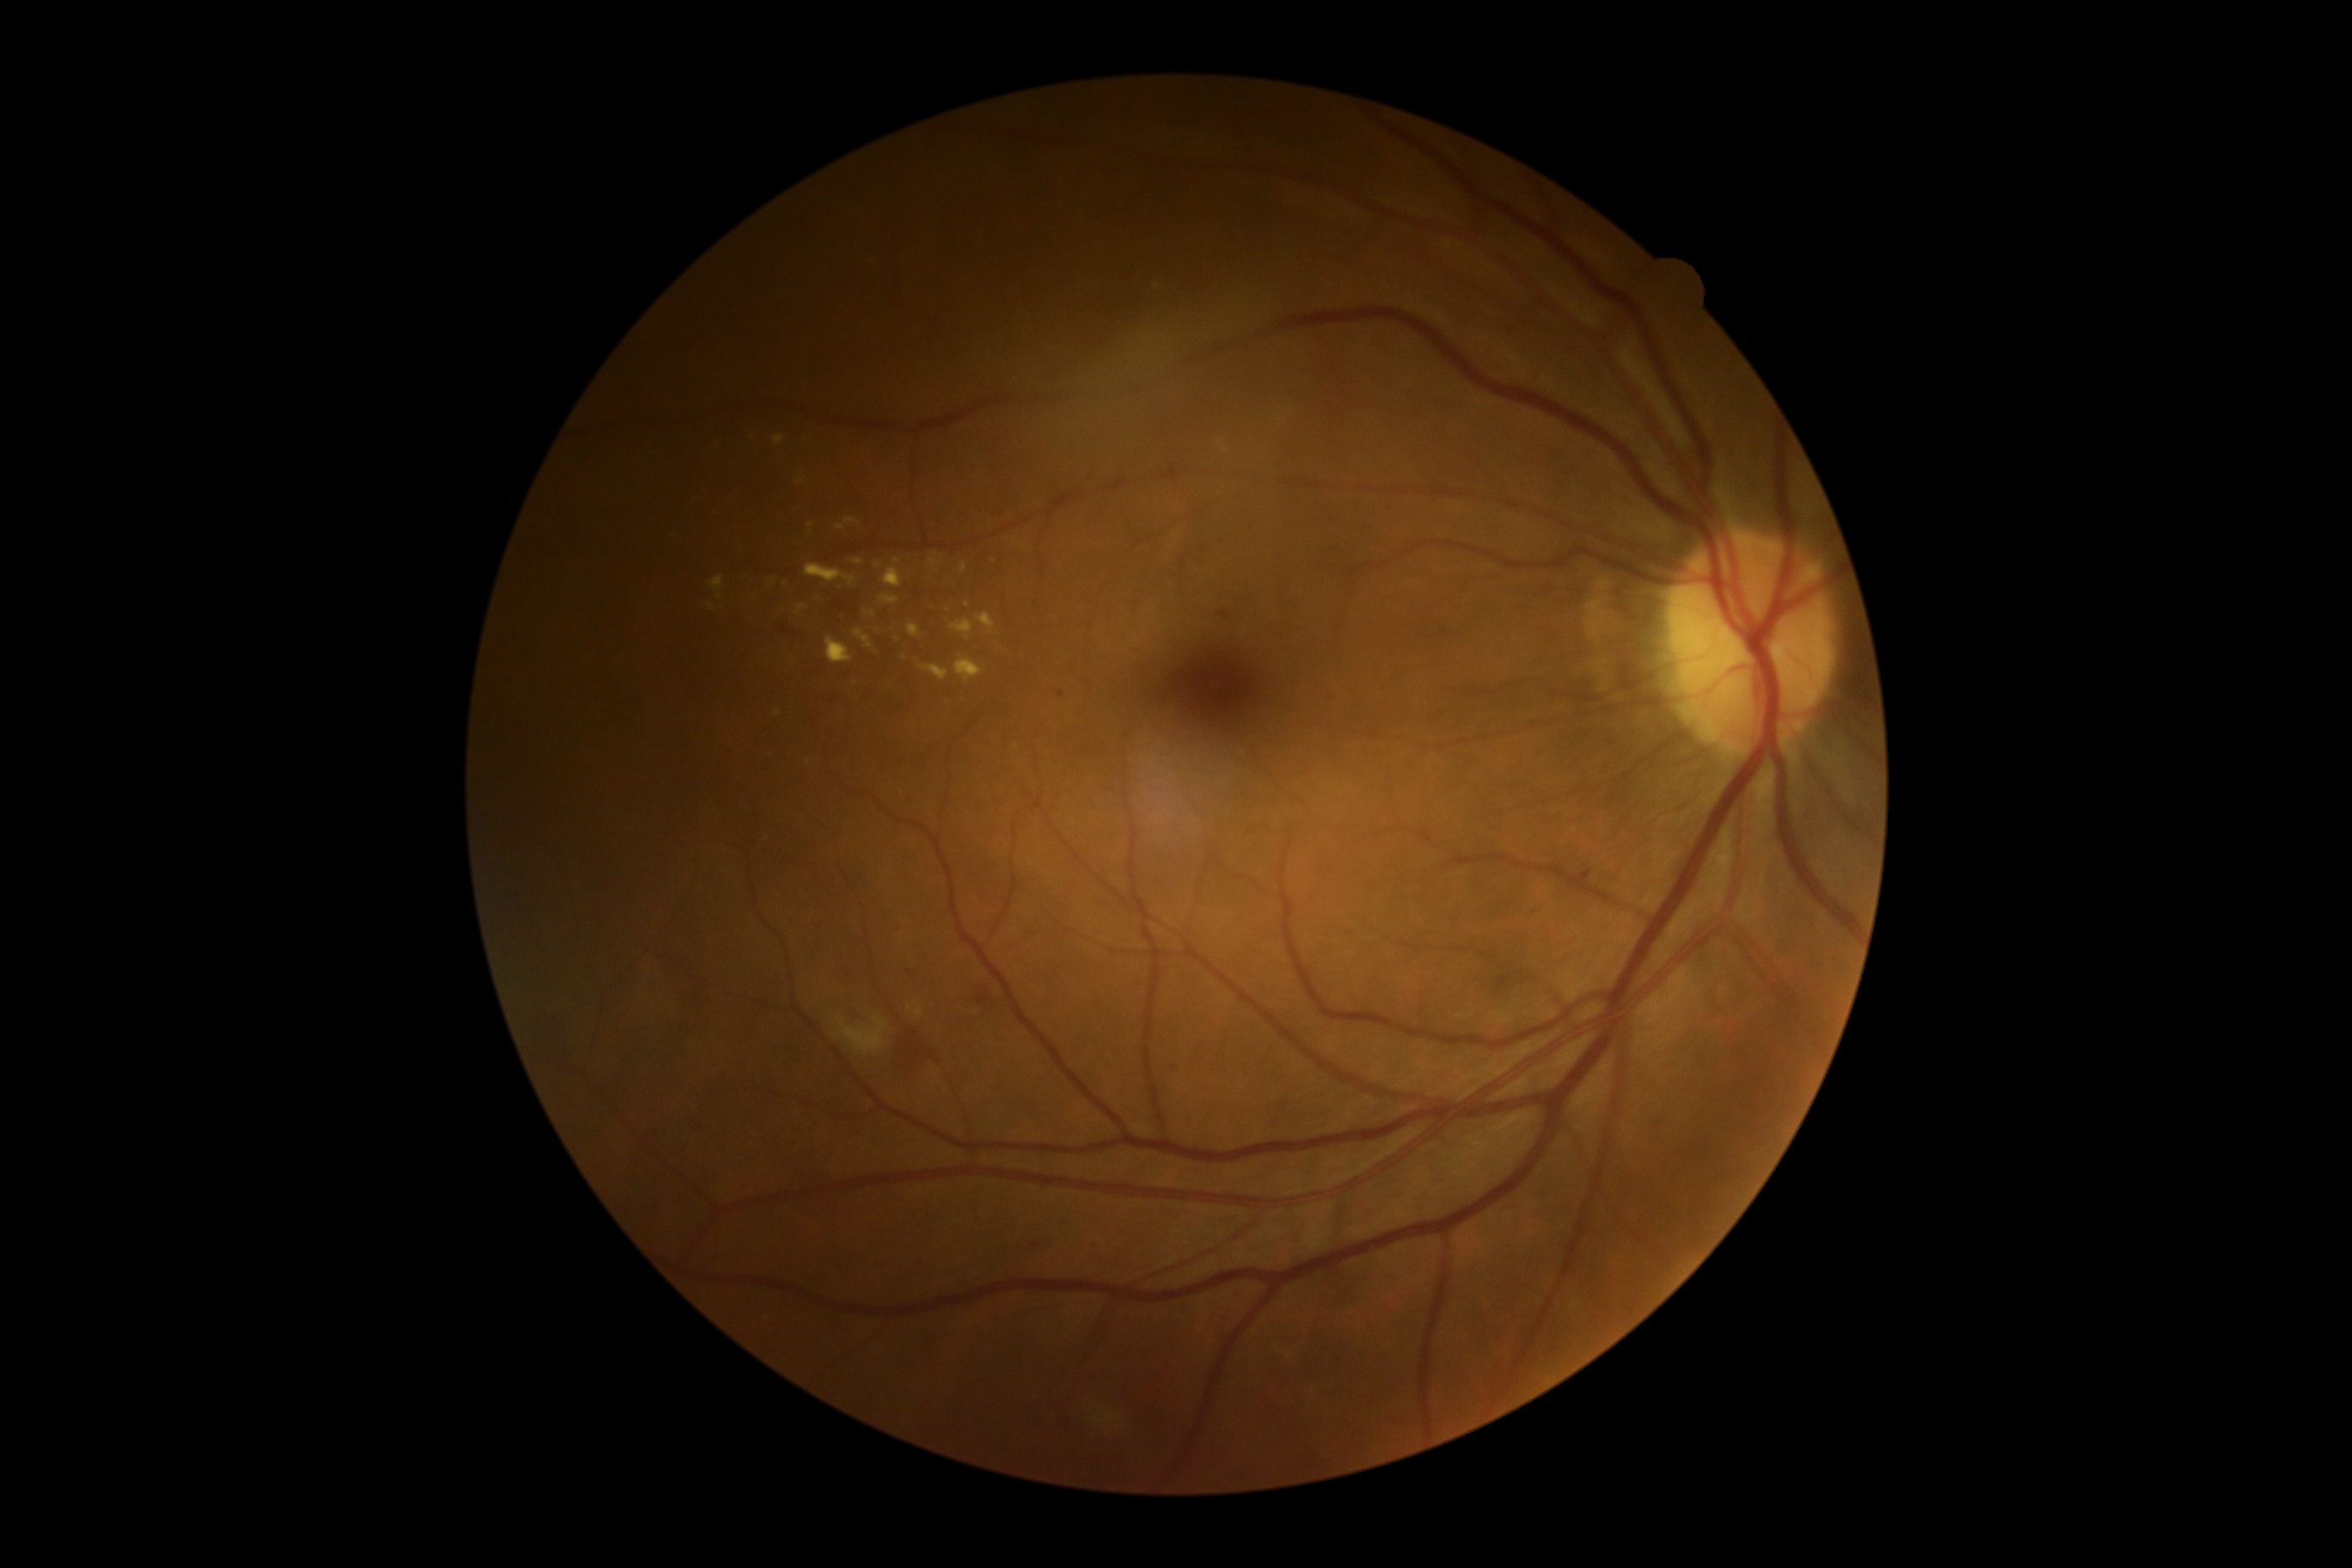 {"partial":true,"dr_grade":2,"dr_grade_name":"moderate NPDR","lesions":{"ex":[[766,579,775,589],[843,517,859,527],[955,656,983,683],[709,577,725,591],[976,613,996,634],[960,561,967,573]],"ex_small_approx":[[716,515],[993,562],[936,556],[711,606],[717,446],[933,562],[867,615],[905,658],[810,526],[873,653]]}}